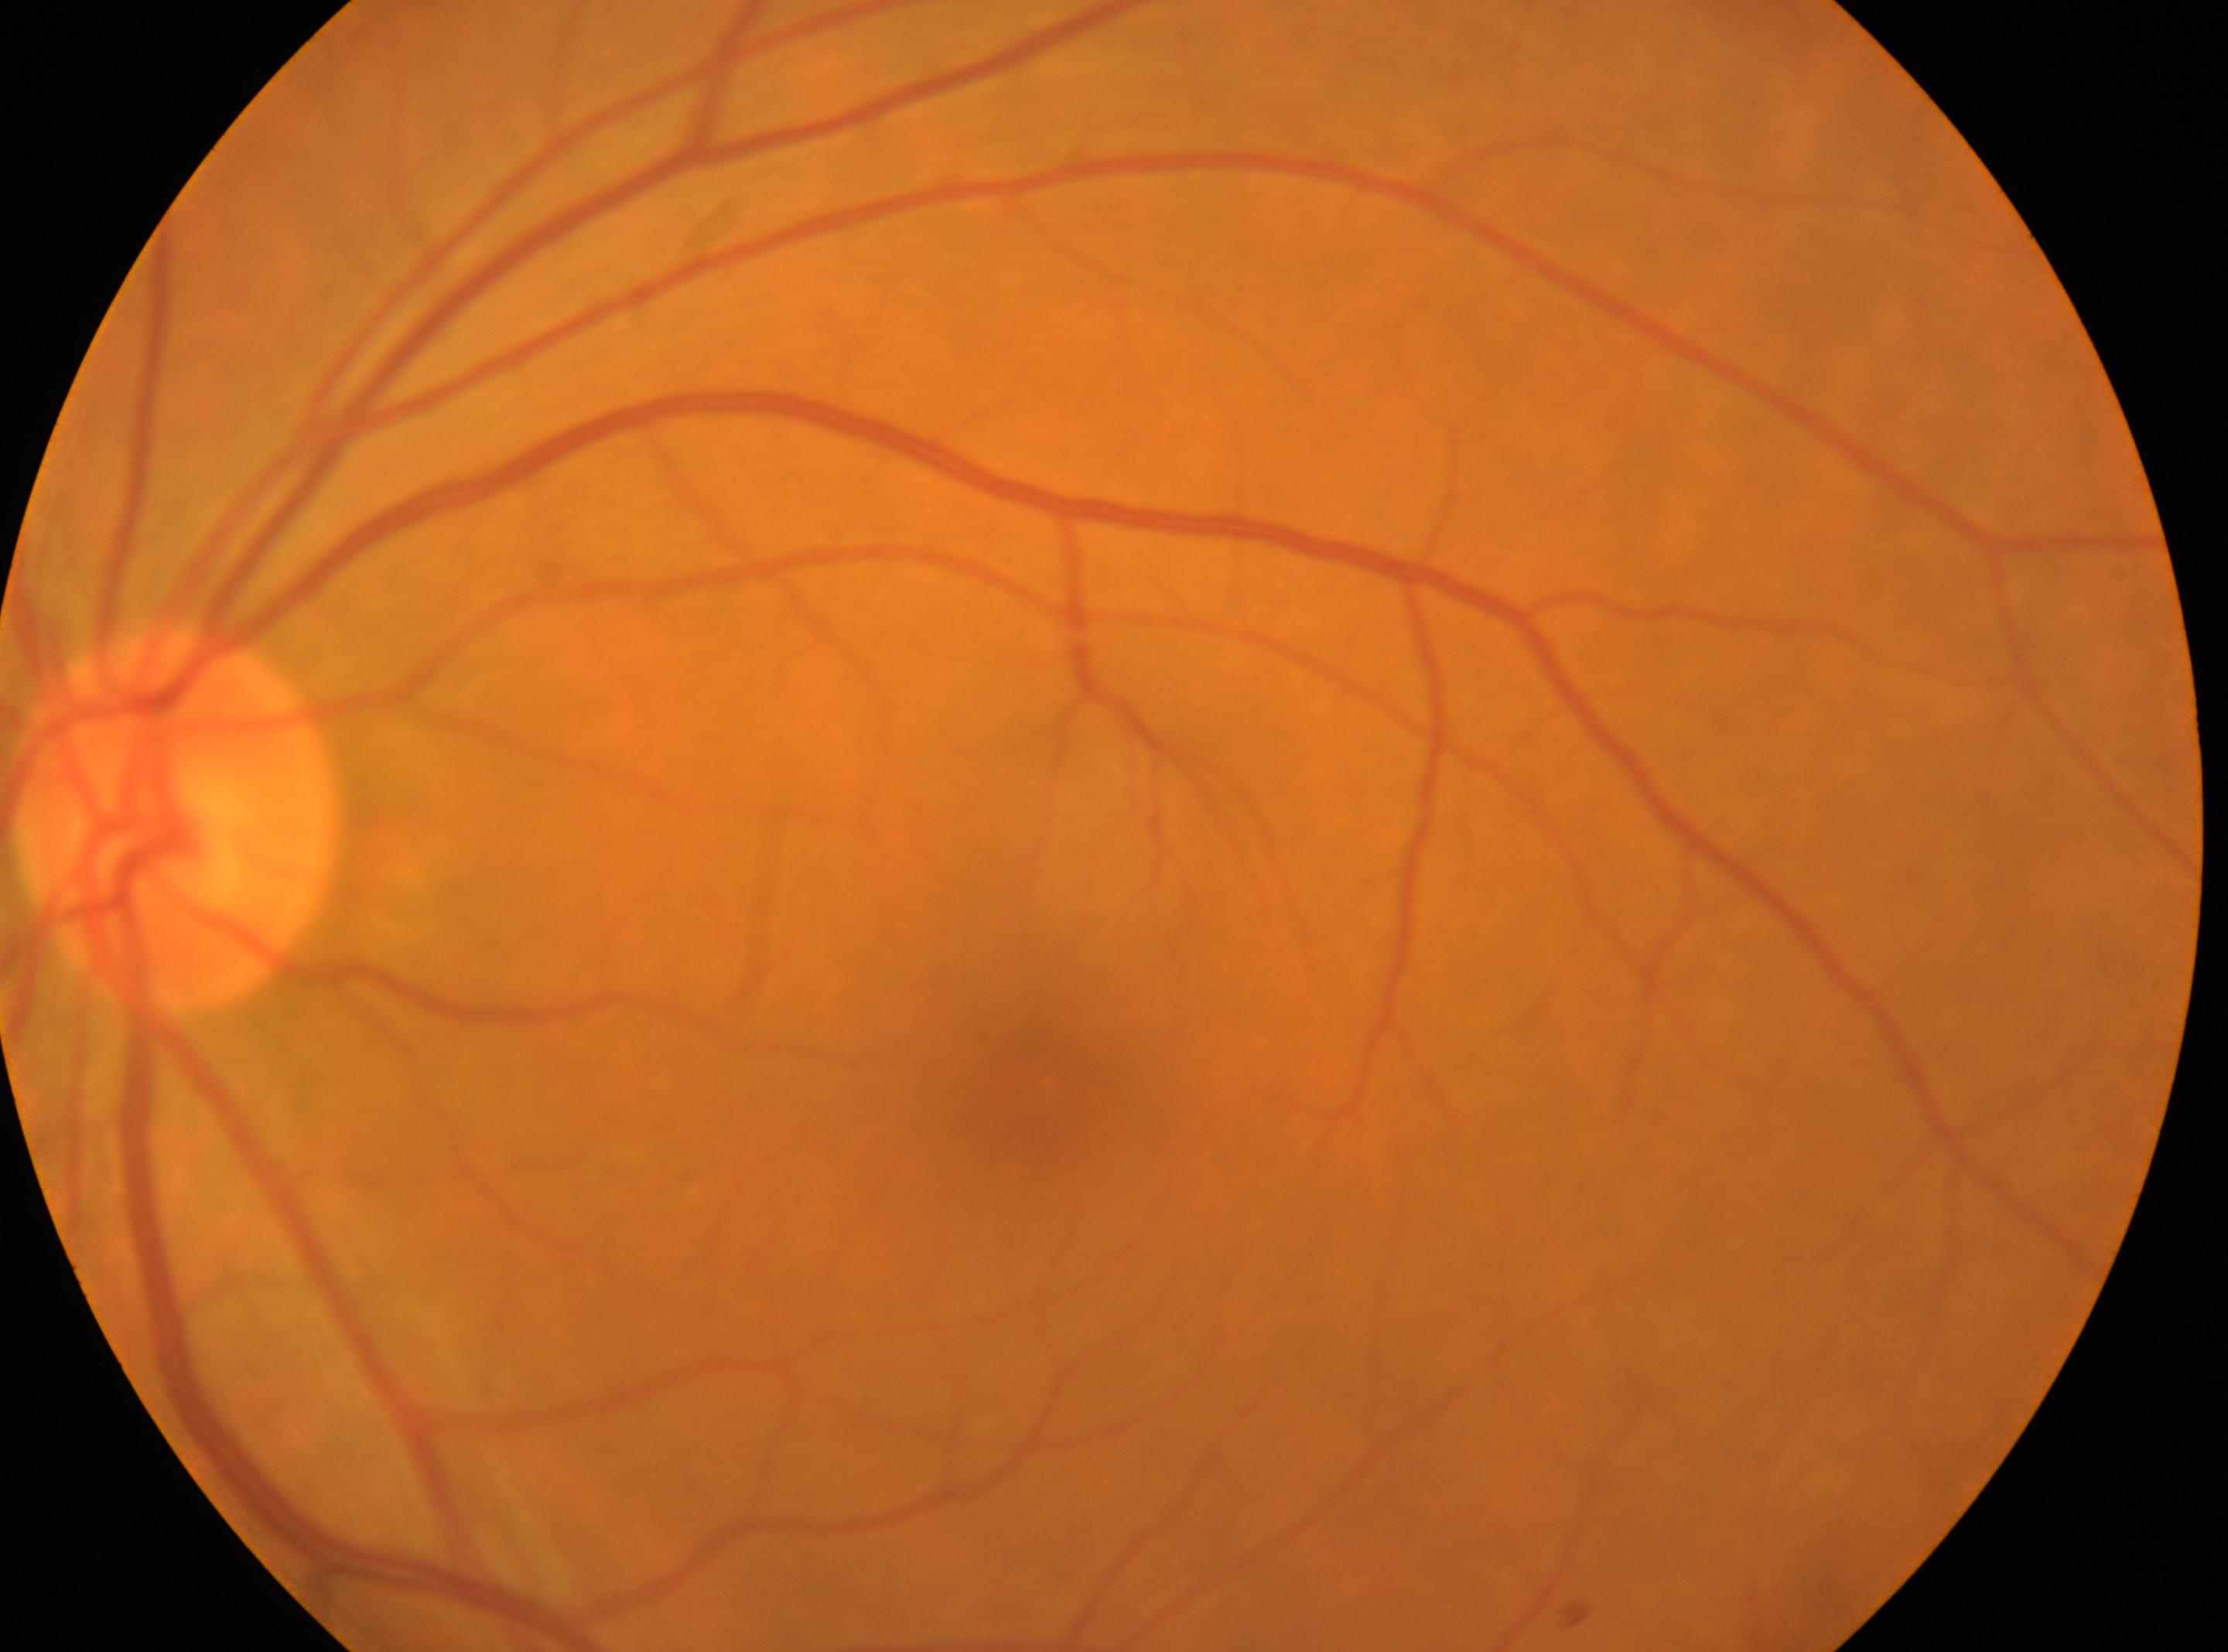
Q: Optic disc center?
A: [176, 821]
Q: What is the laterality?
A: OS
Q: Fovea center?
A: [1034, 1080]
Q: Diabetic retinopathy severity?
A: grade 0 (no apparent retinopathy)